RetCam wide-field infant fundus image
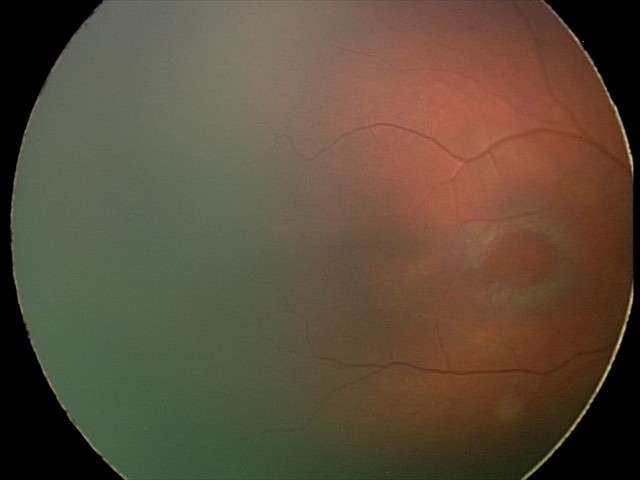

Q: What is the screening diagnosis?
A: normal fundus examination